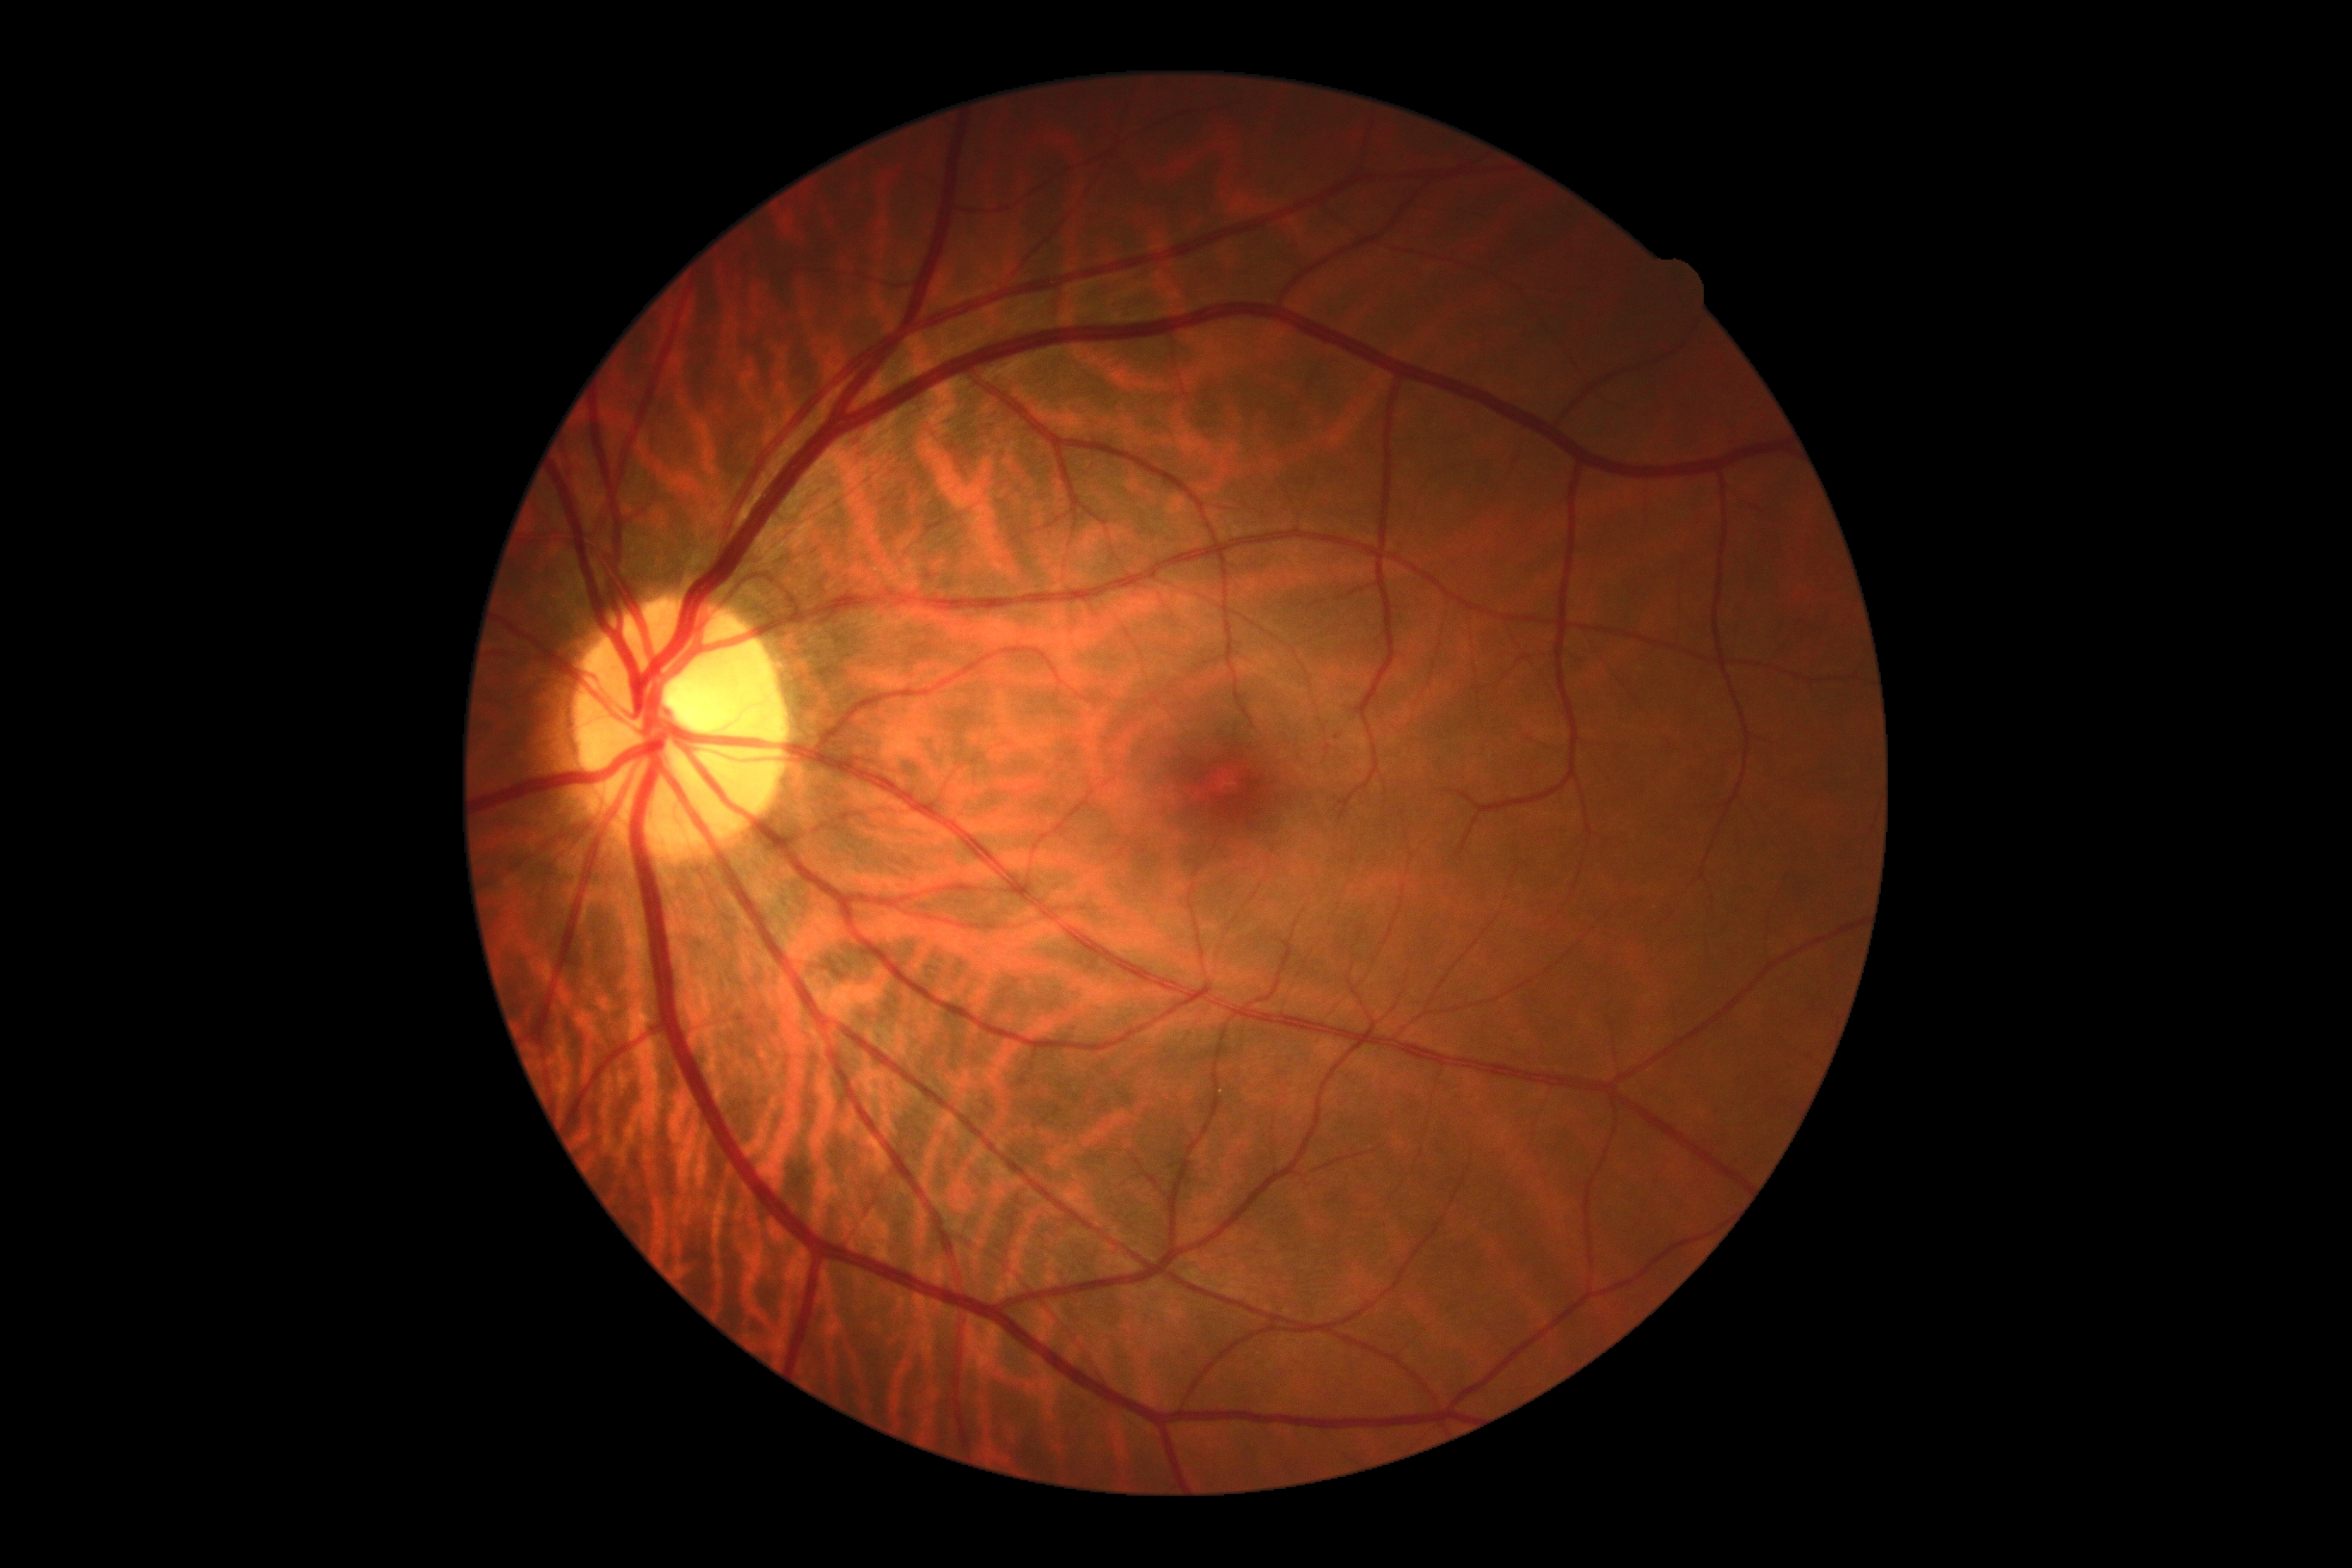

No signs of diabetic retinopathy. Retinopathy grade: 0.